848x848px:
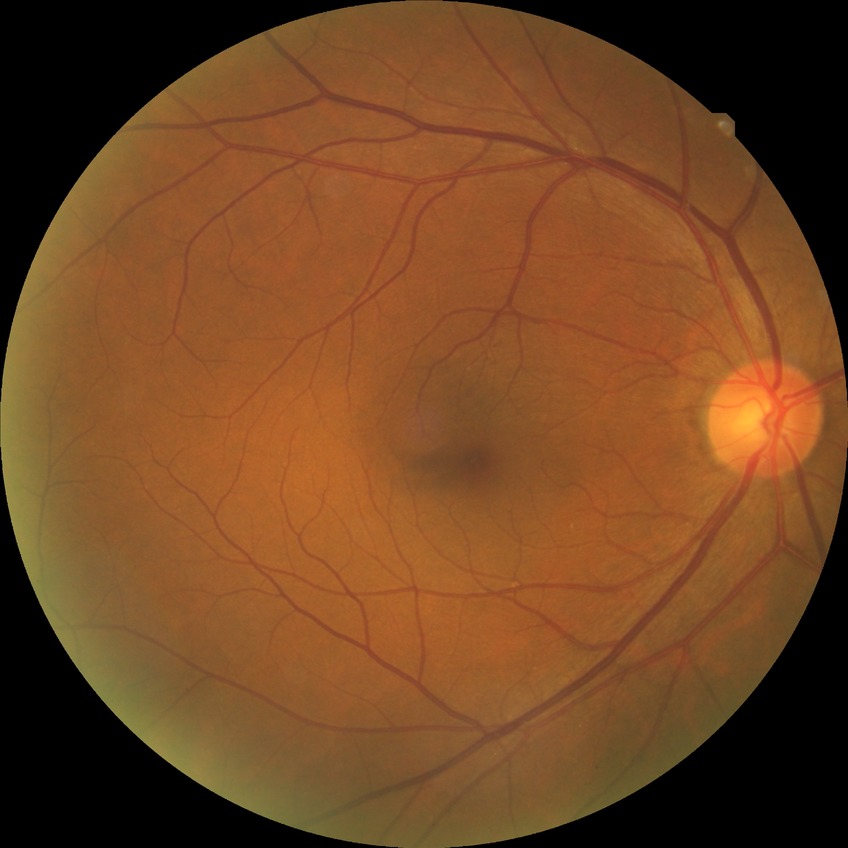 diabetic retinopathy (DR)@no diabetic retinopathy (NDR).